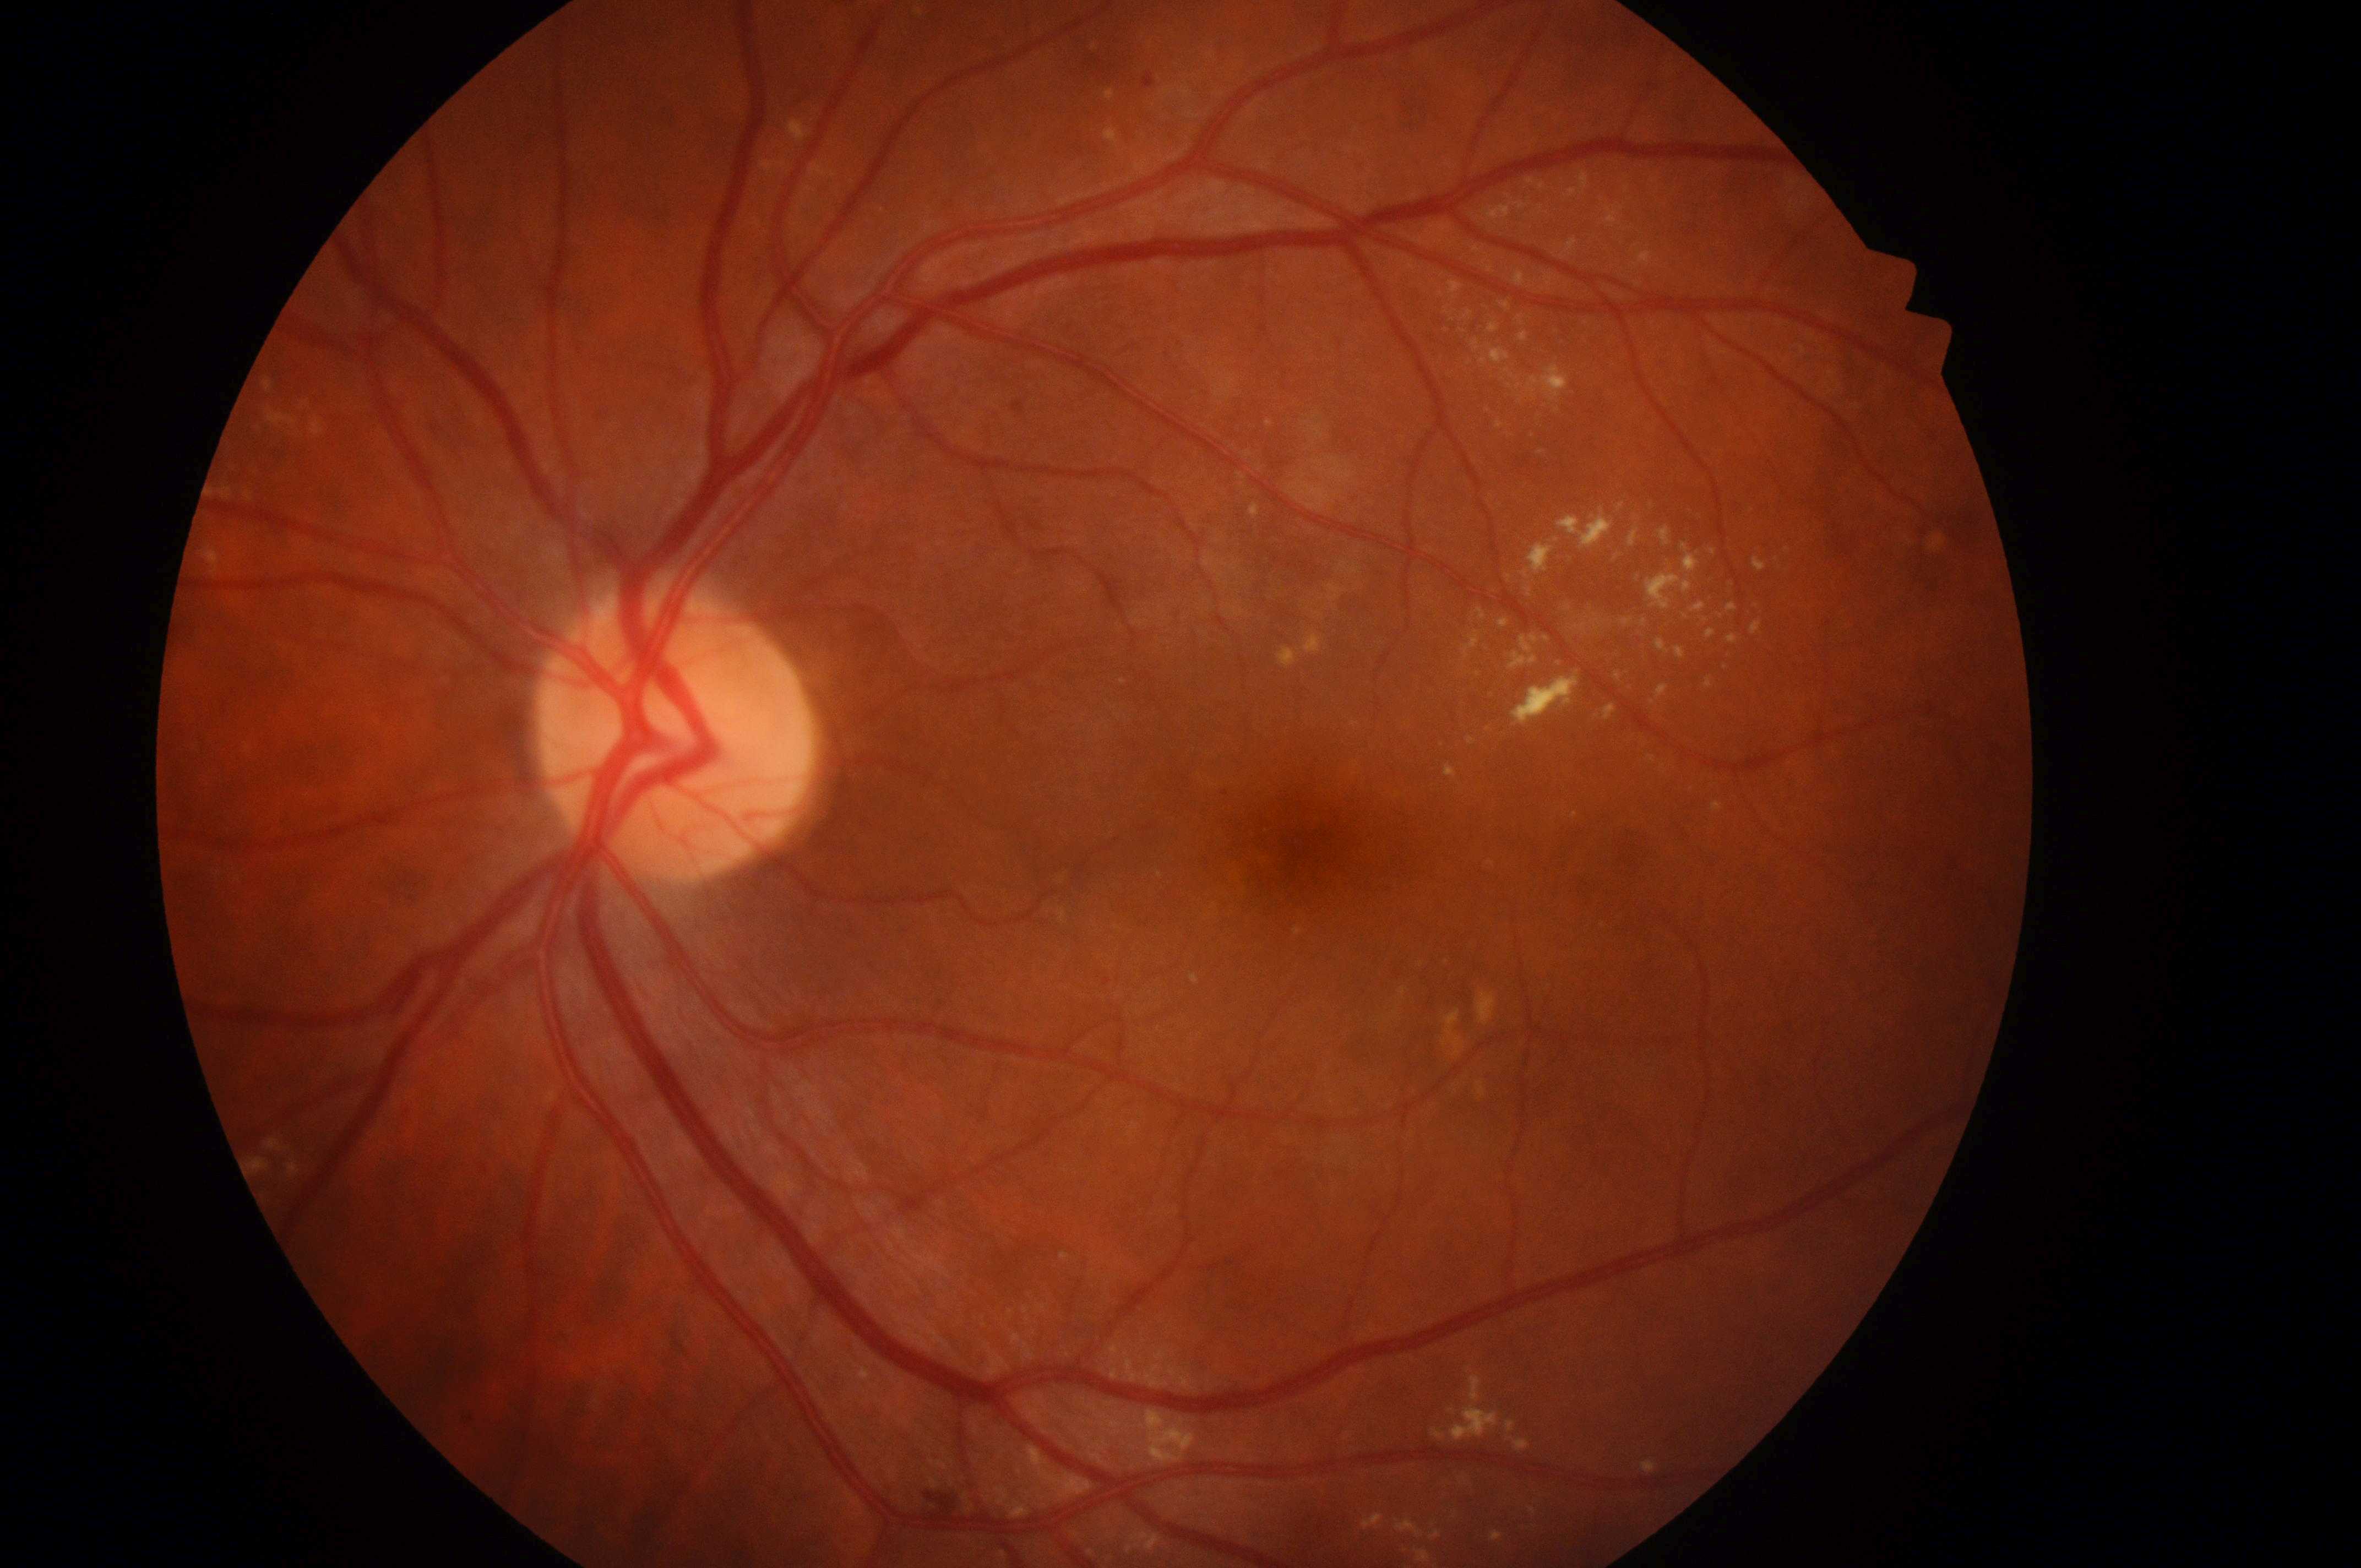
laterality = oculus sinister; DME = high risk (grade 2); macula center = x=1316, y=851; DR grade = moderate non-proliferative diabetic retinopathy (2); optic disc = x=670, y=746.